No pharmacologic dilation. 45° FOV. 848x848px. Acquired with a NIDEK AFC-230 — 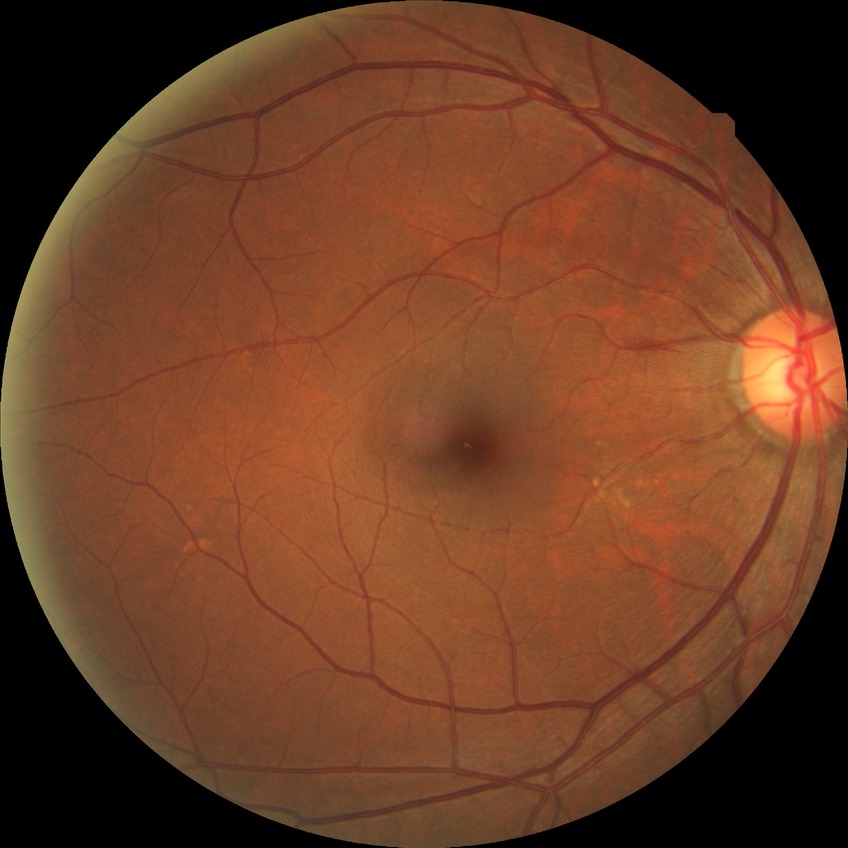

diabetic retinopathy (DR): NDR (no diabetic retinopathy)